Macula-centered field; CFP; 50° field of view — 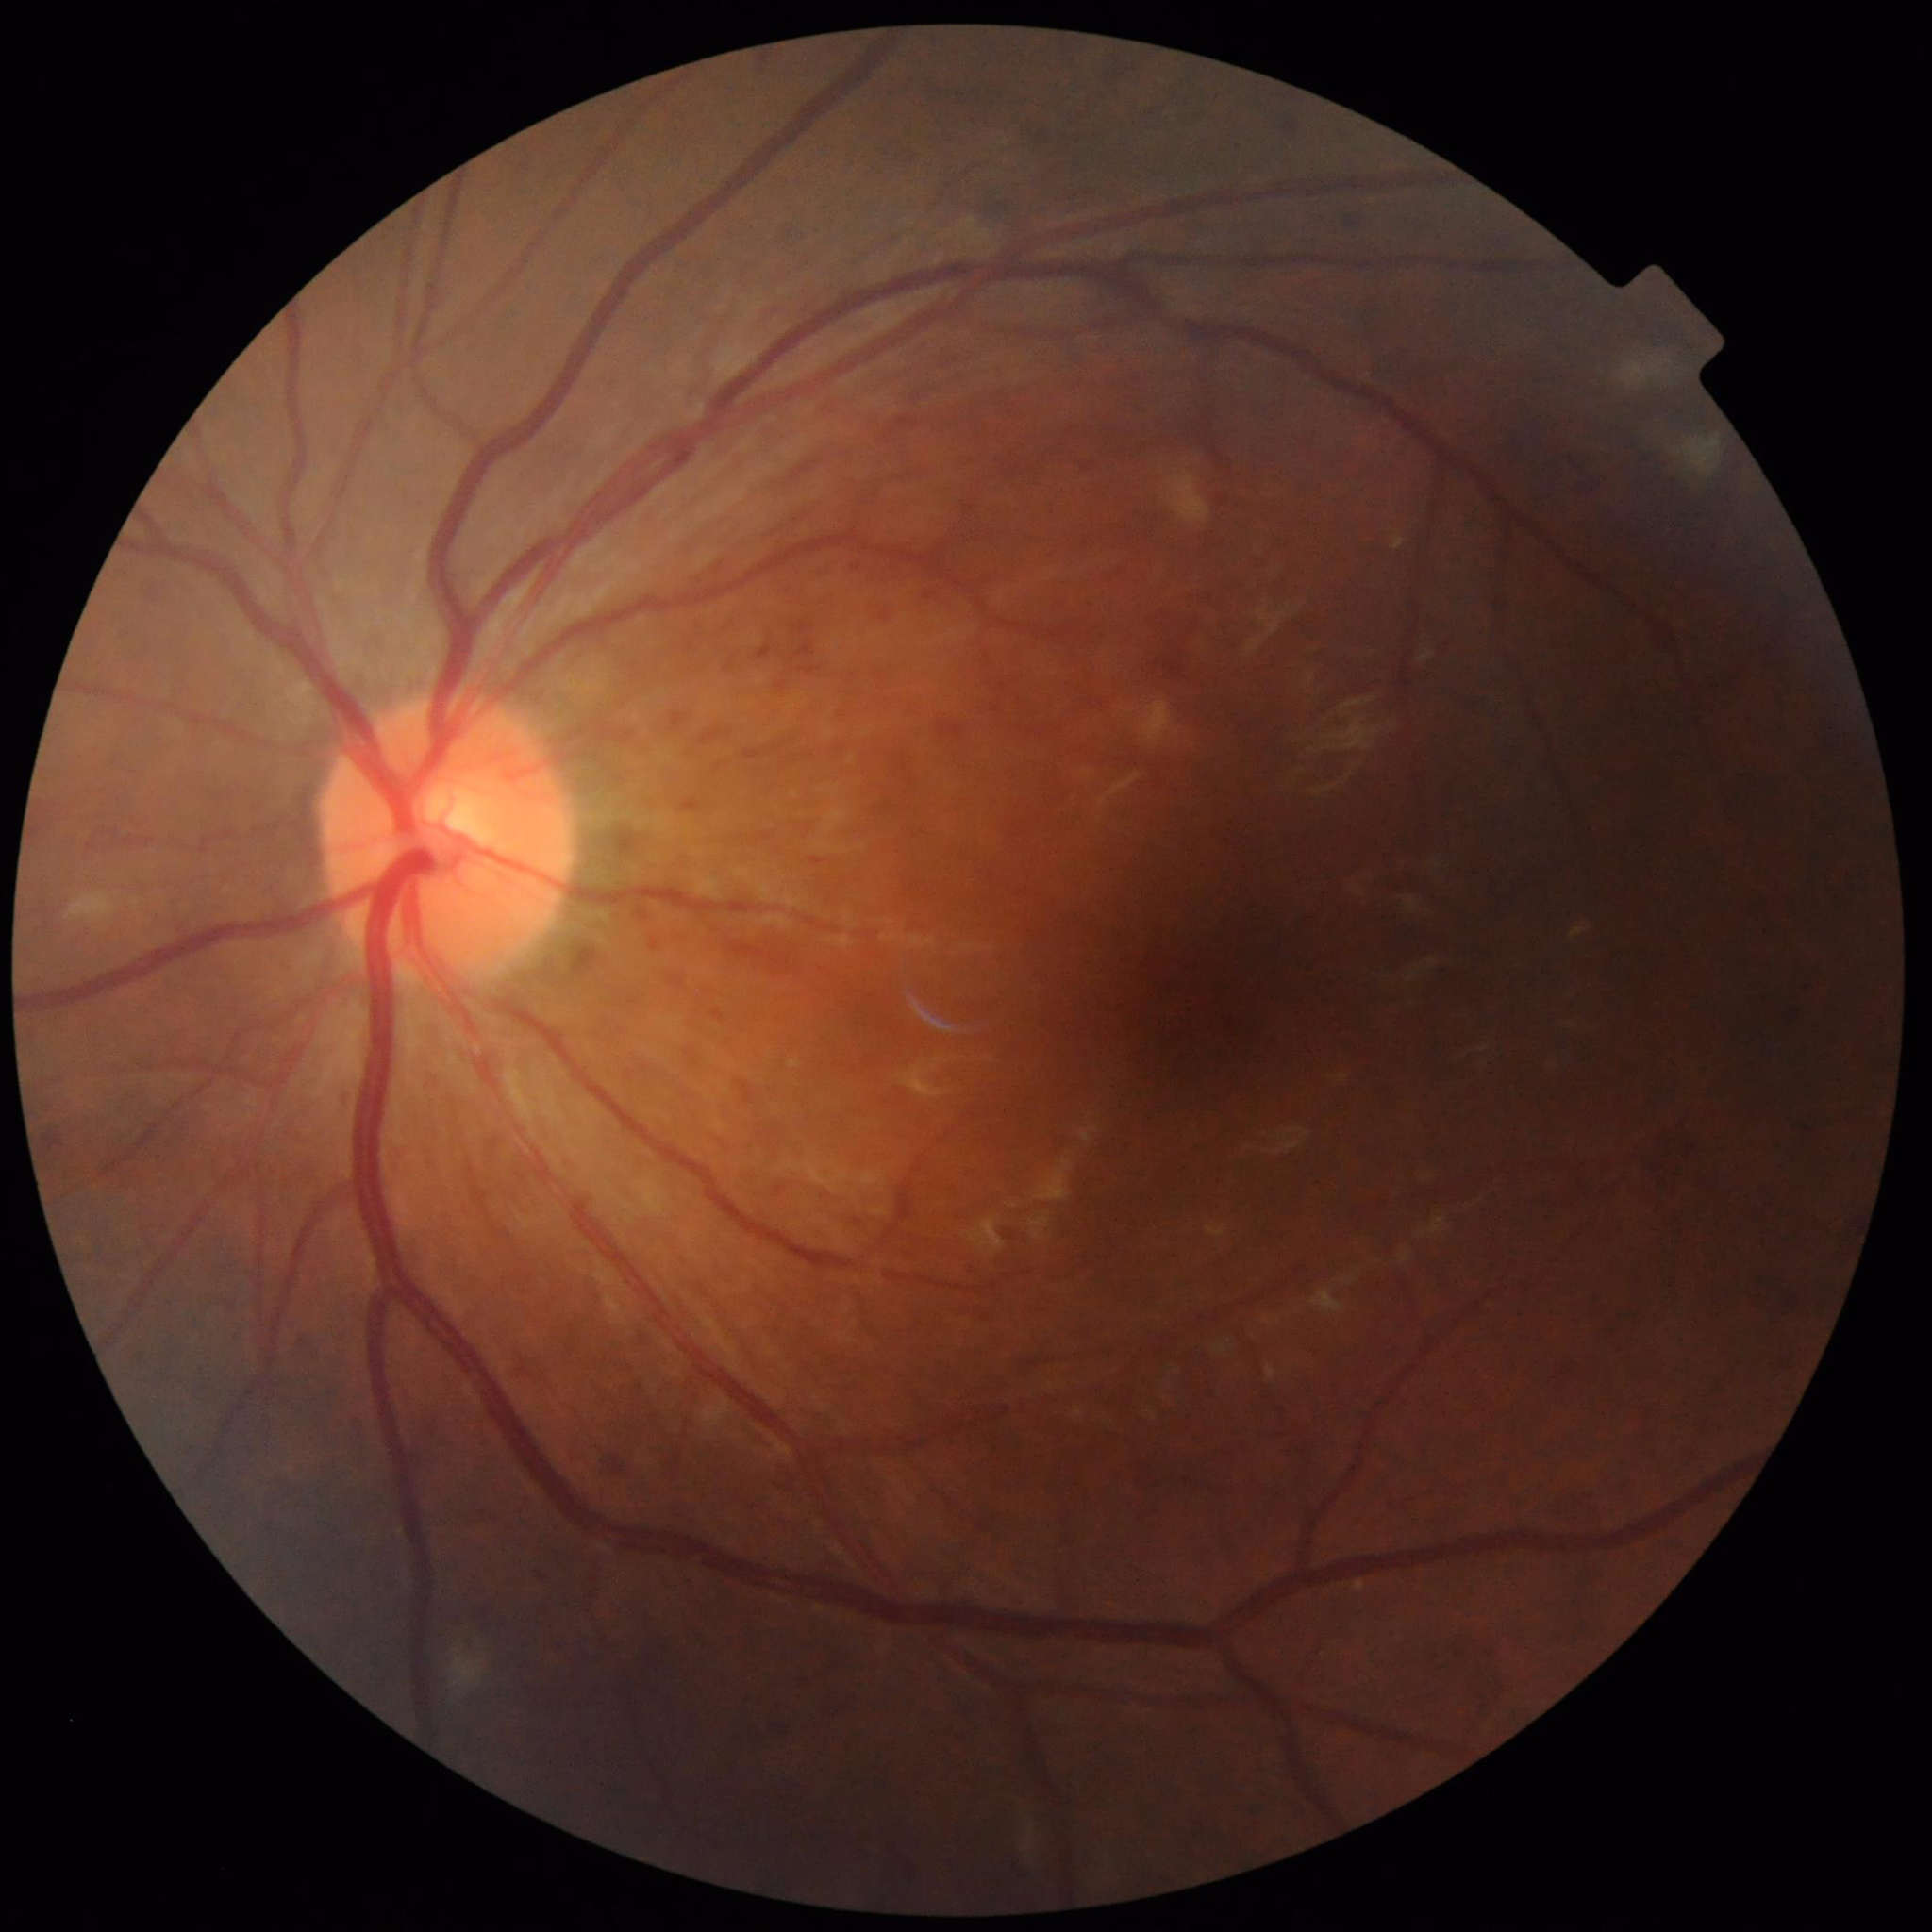 Disease = diabetic retinopathy (DR); Automated quality assessment = poor — illumination/color distortion.